FOV: 45 degrees: 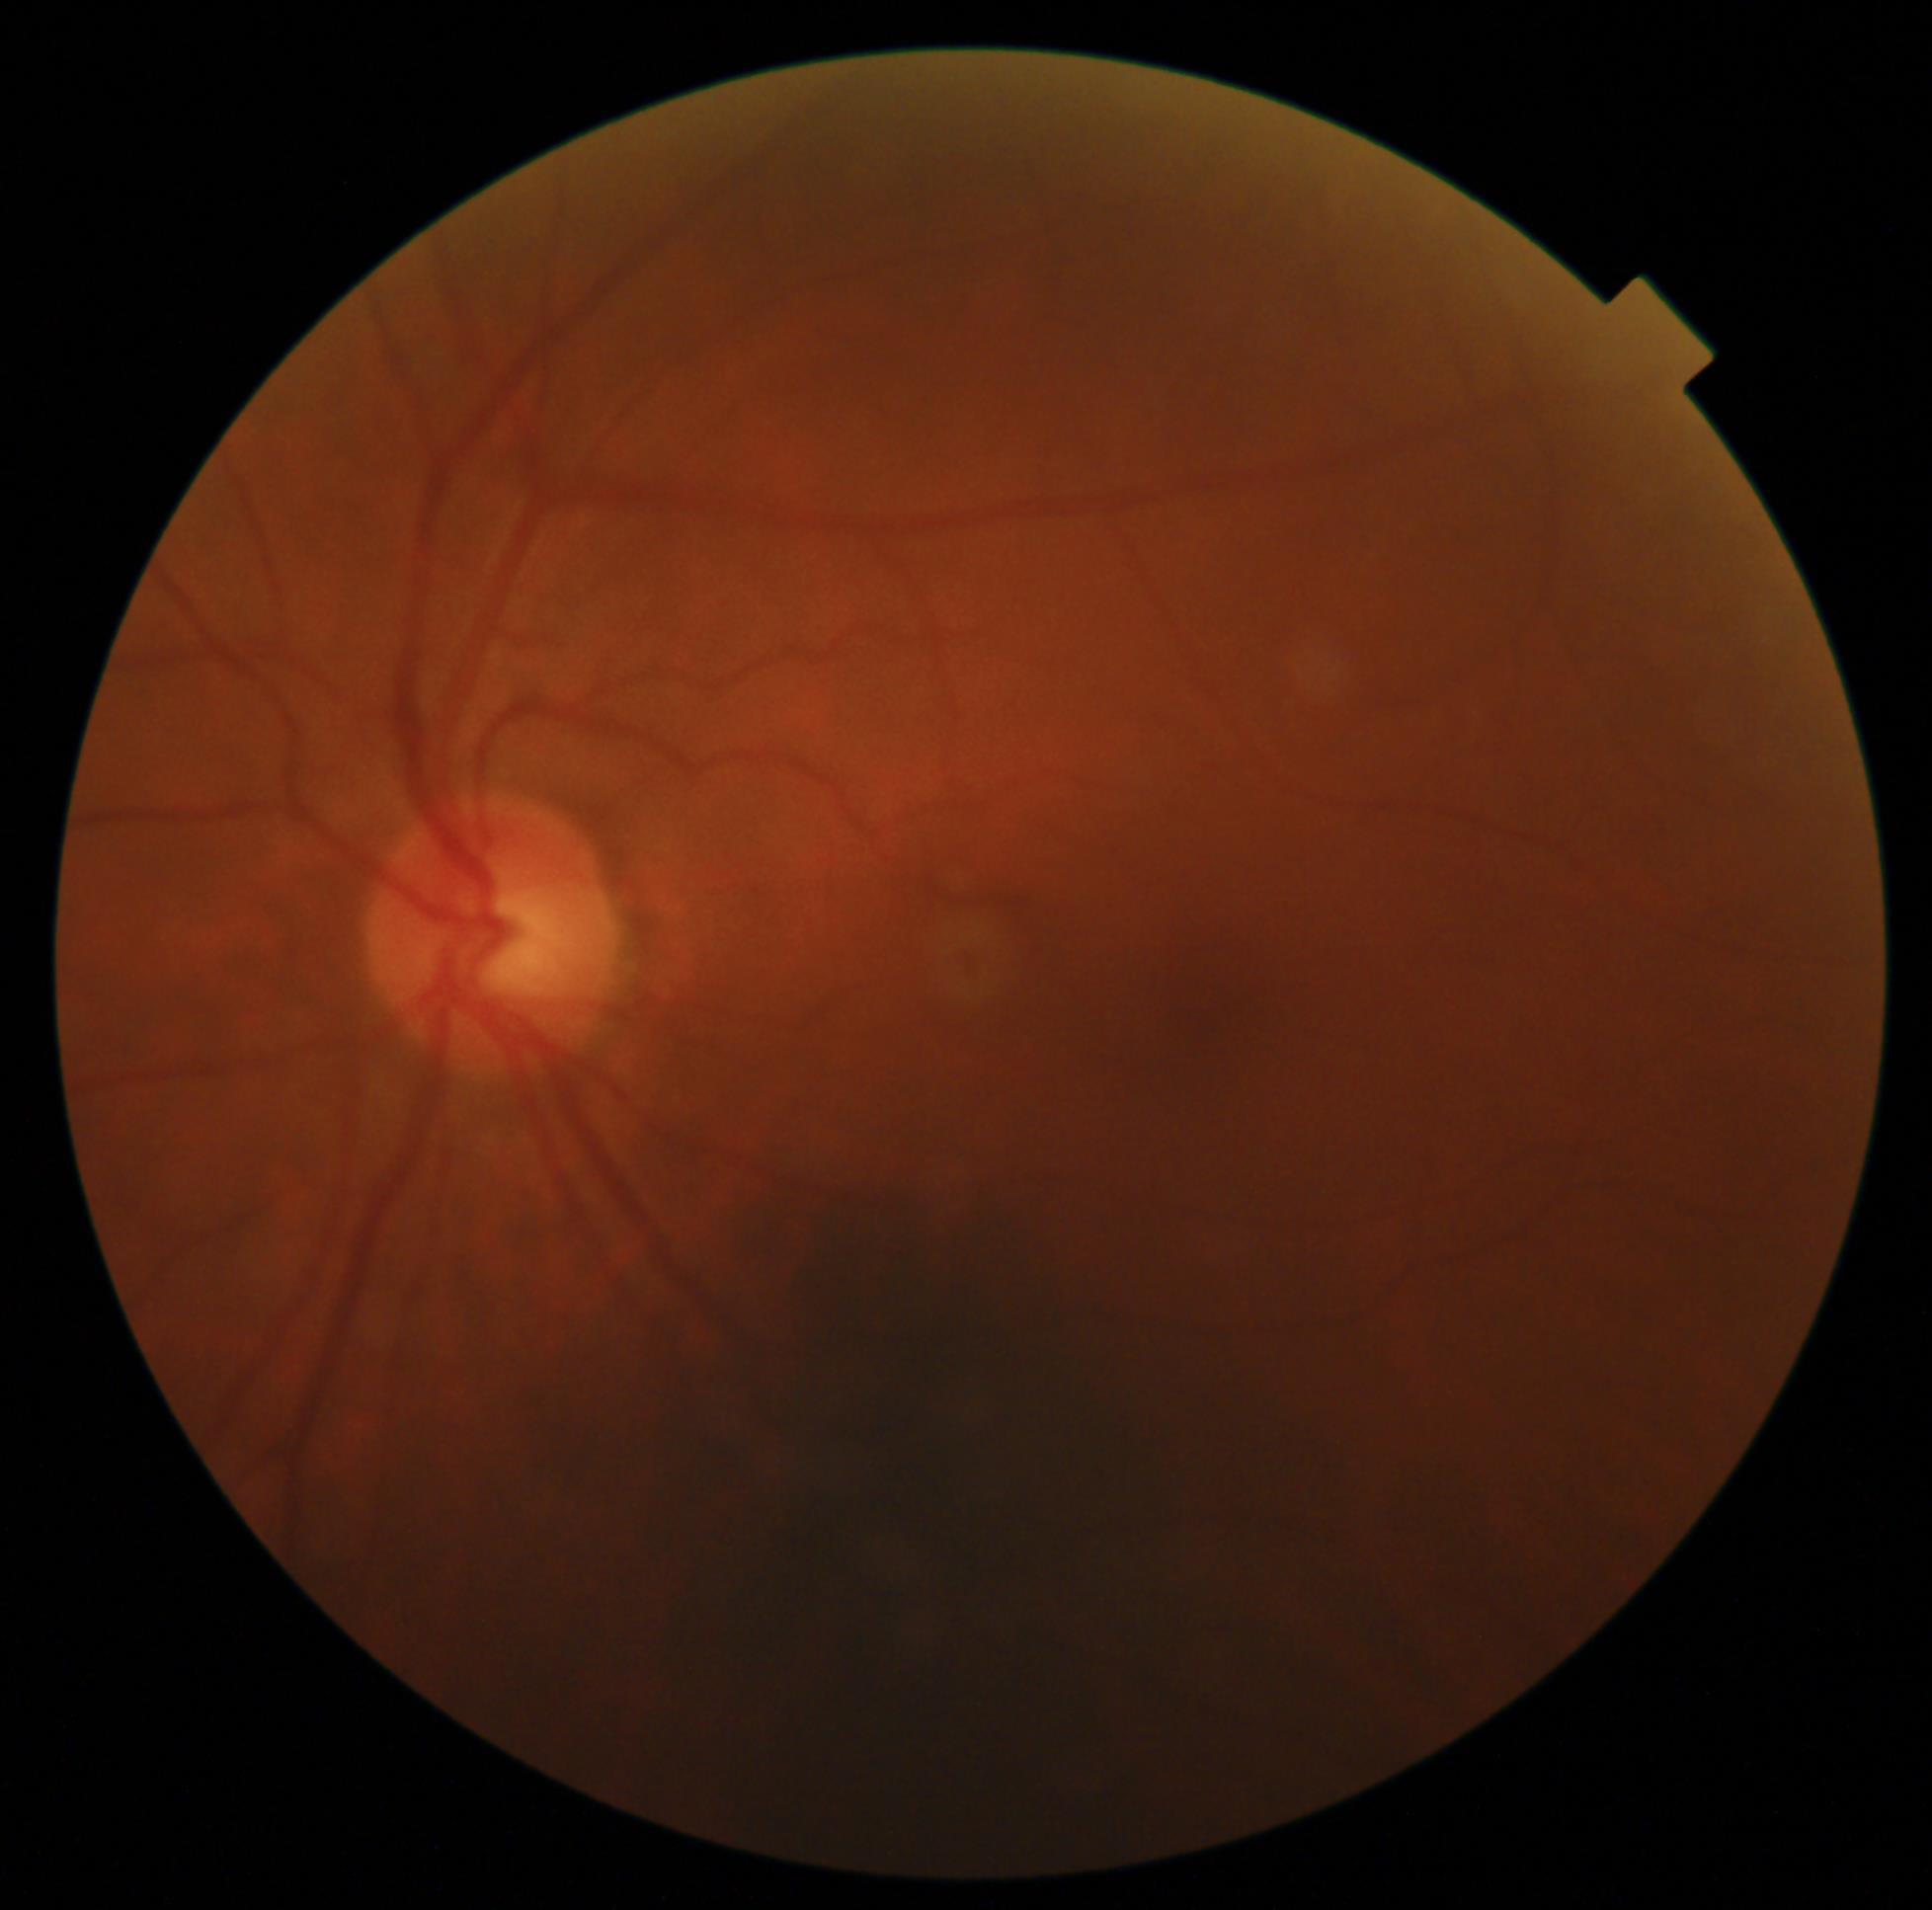 DR stage=0/4.